Image size 640x480 · RetCam wide-field infant fundus image · camera: Clarity RetCam 3 (130° FOV)
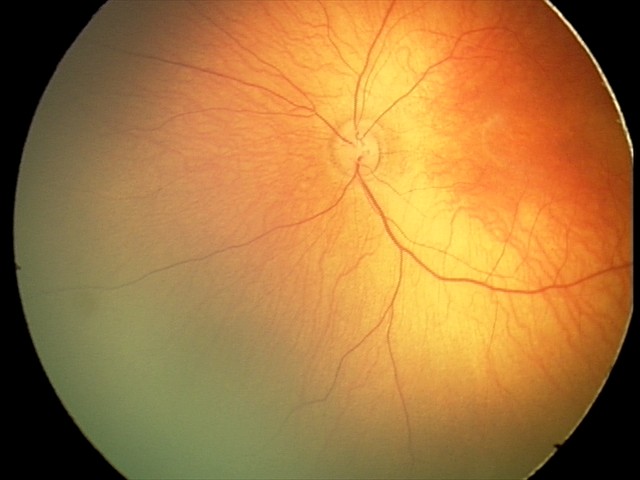 From an examination with diagnosis of retinal hemorrhages.